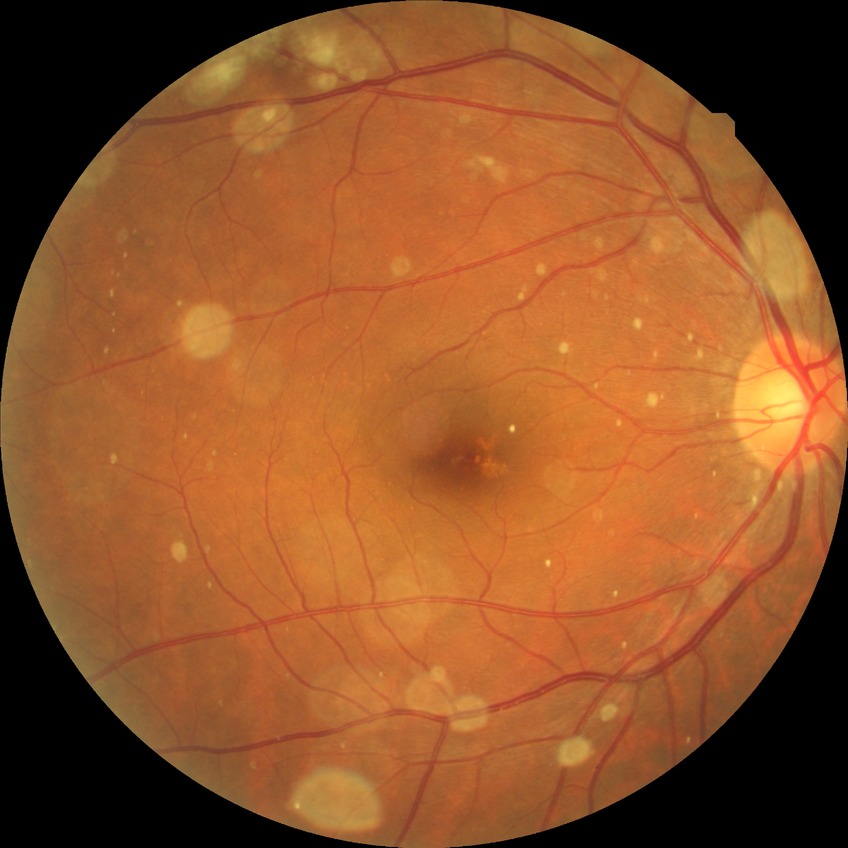 {
  "davis_grade": "NDR (no diabetic retinopathy)"
}